2352x1568
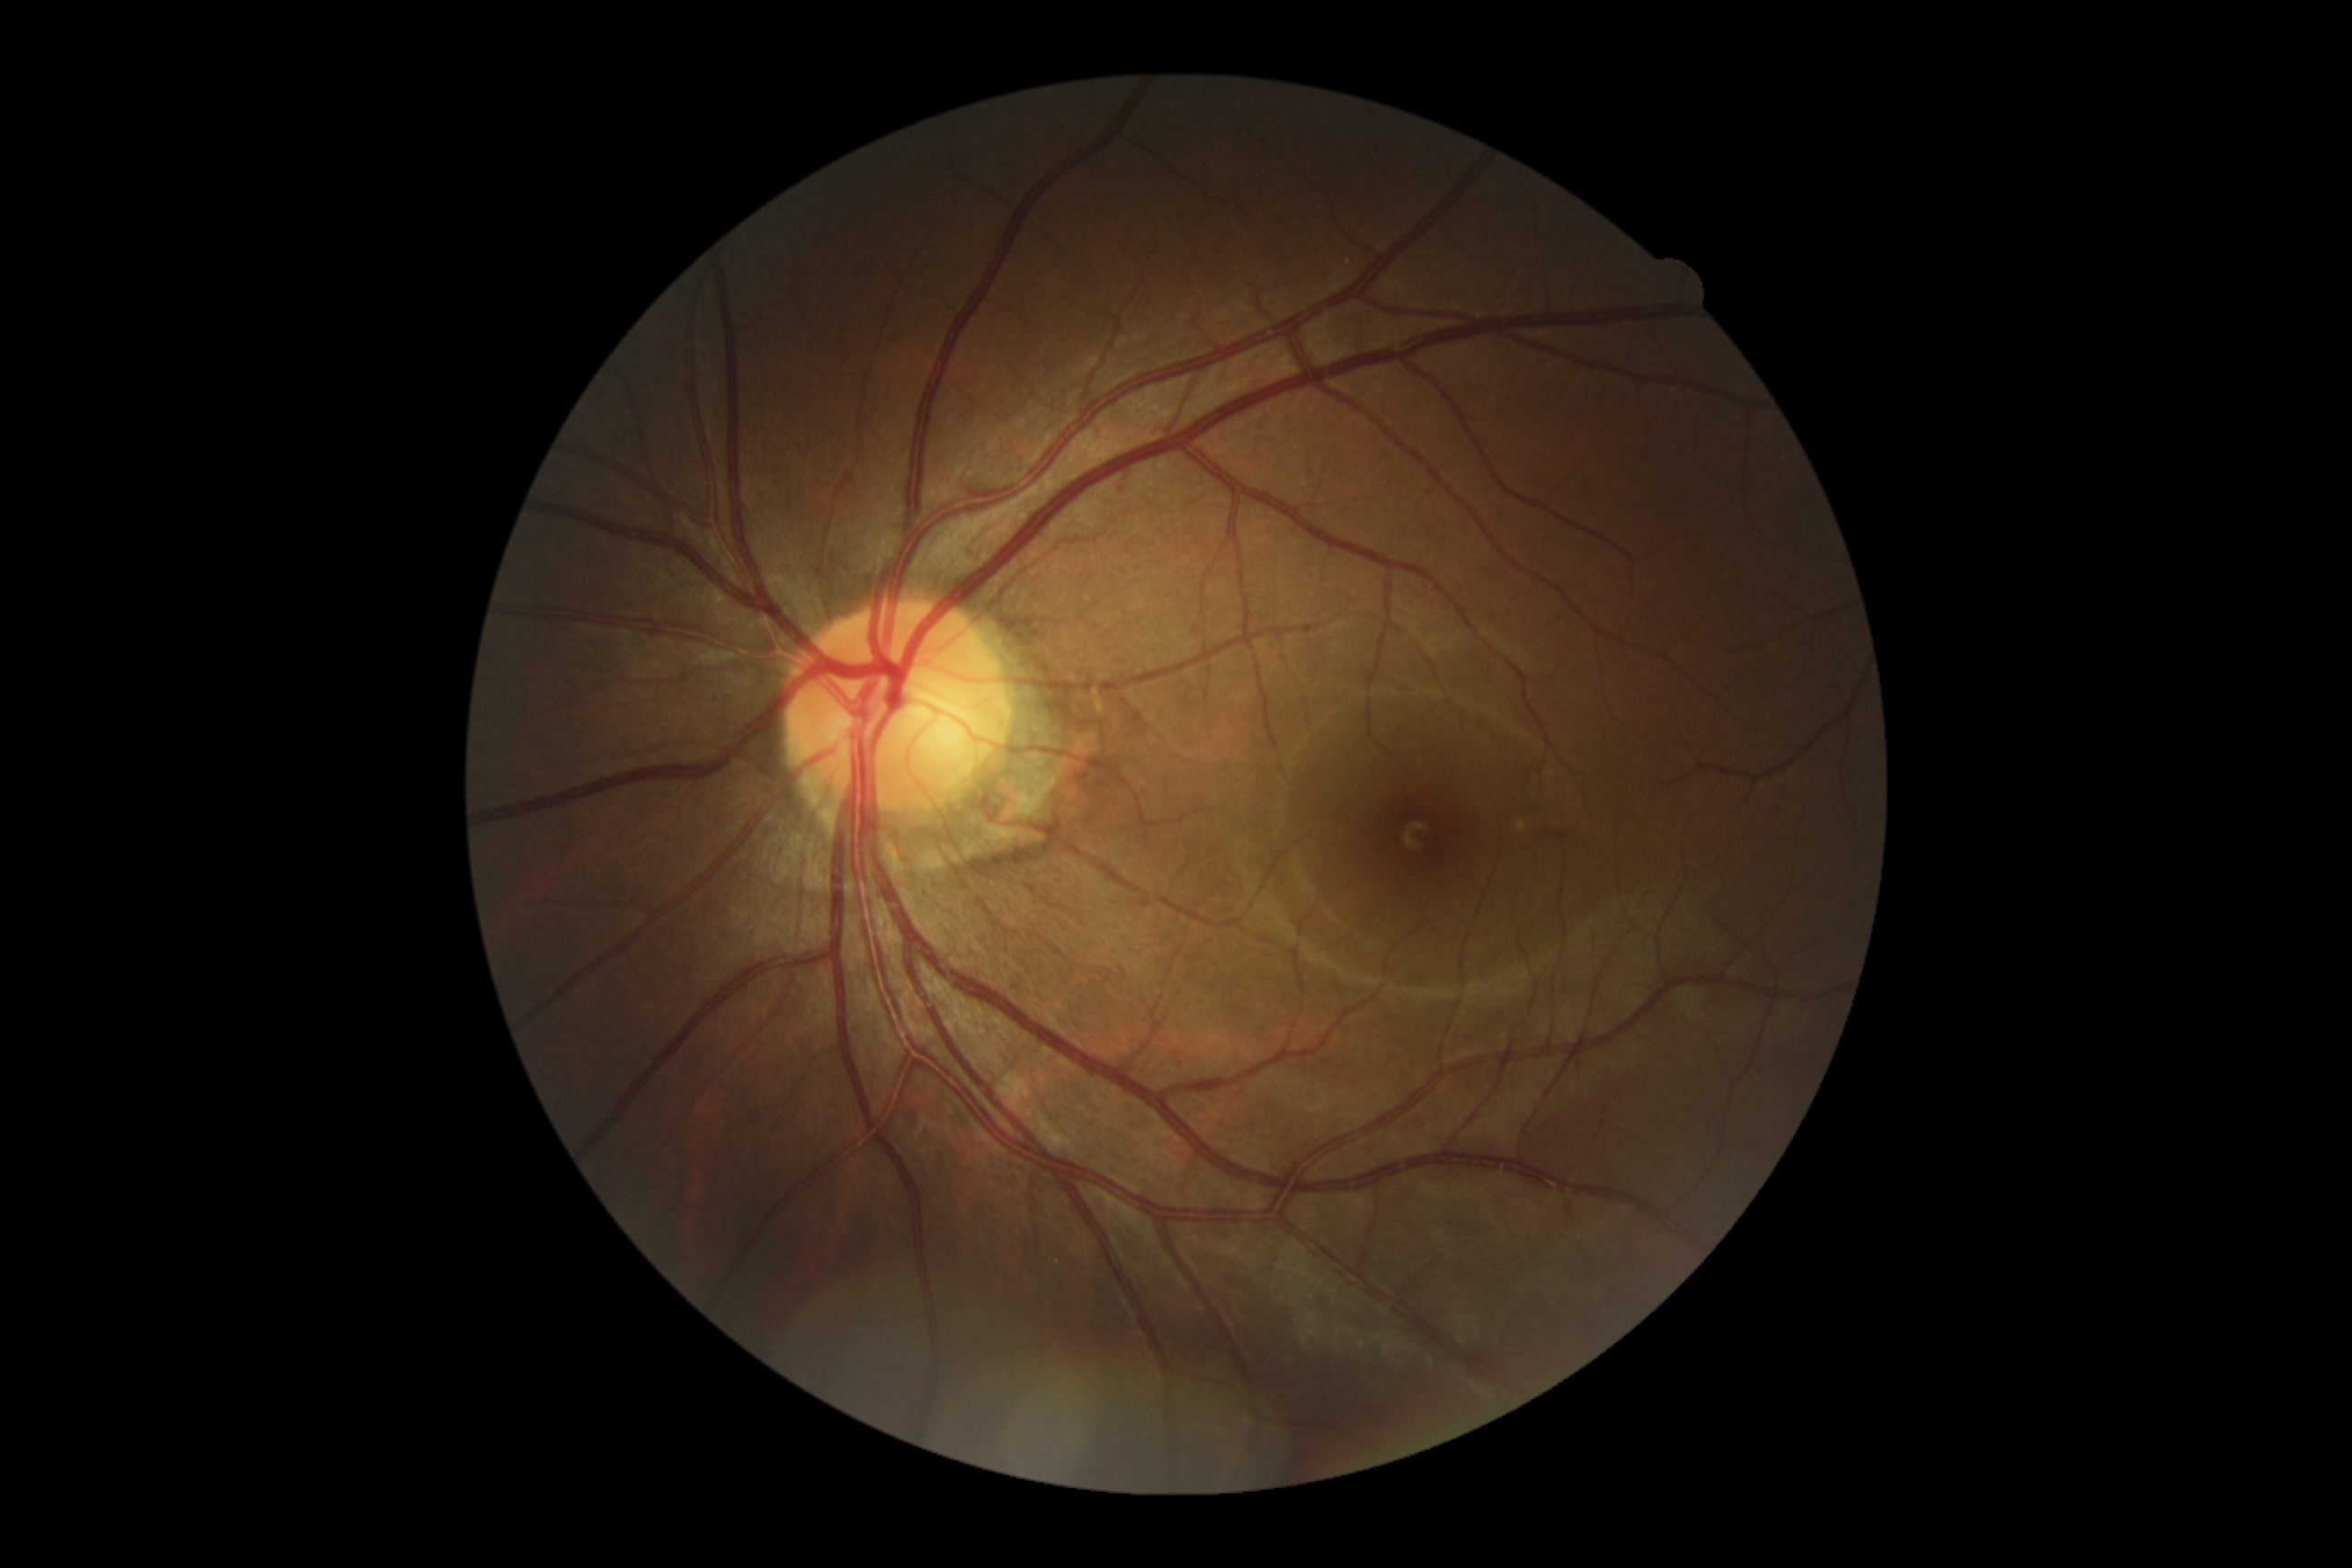
DR is no apparent diabetic retinopathy (grade 0).